Wide-field contact fundus photograph of an infant · captured with the Phoenix ICON (100° field of view): 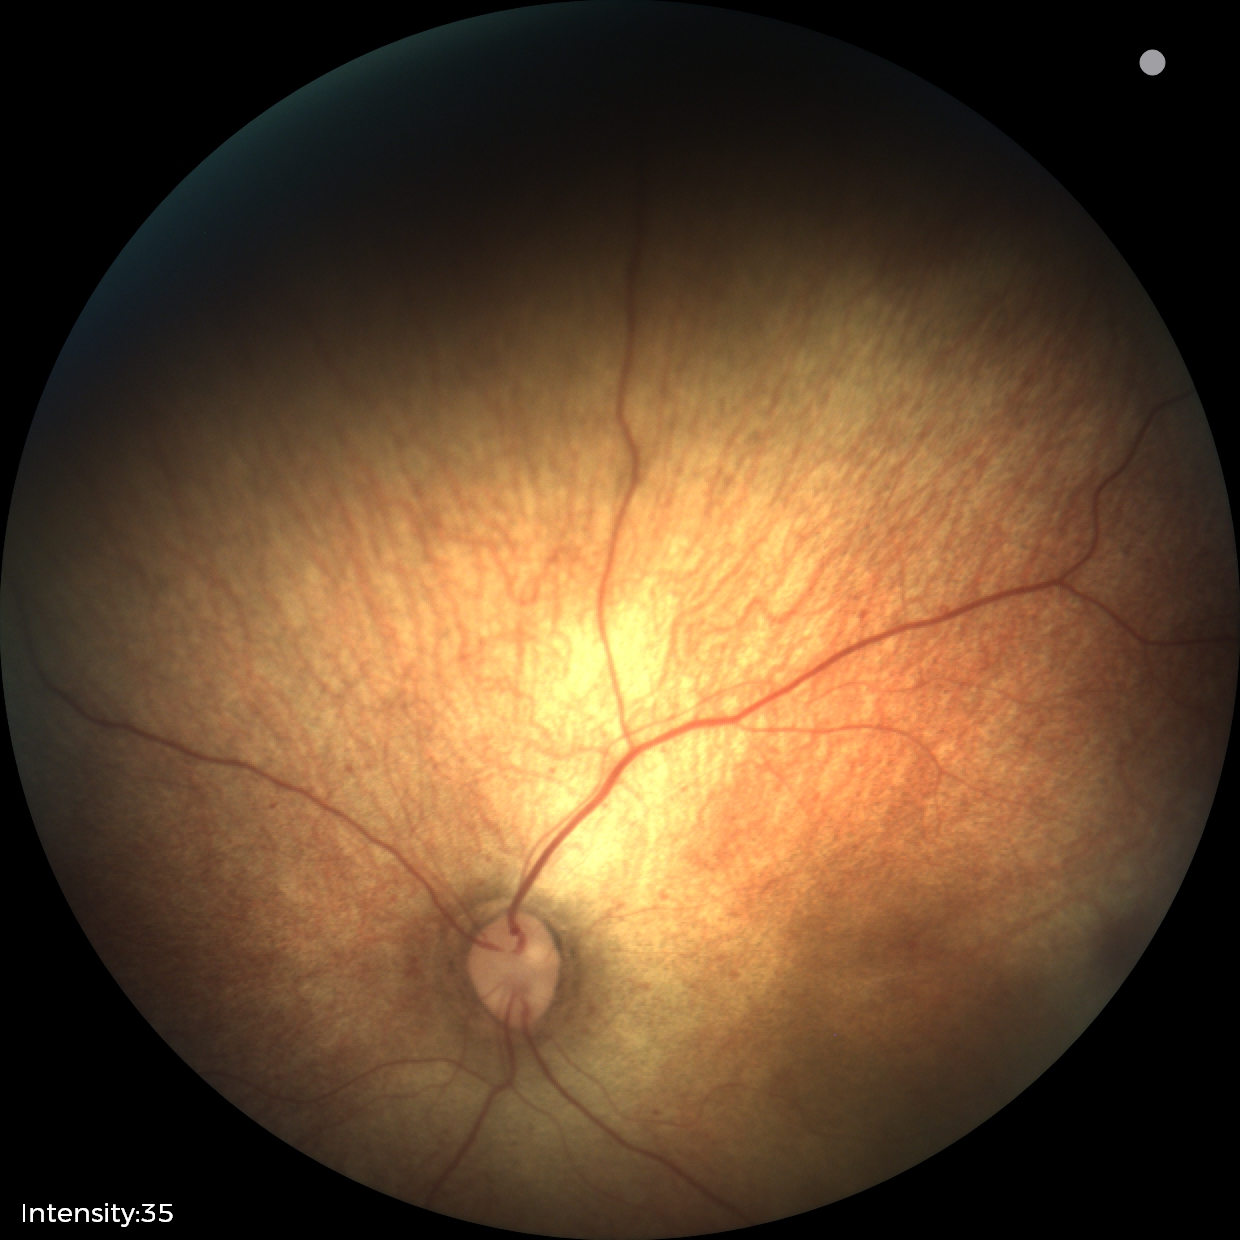
Impression: normal fundus examination.